Fundus photo. 1444x1444: 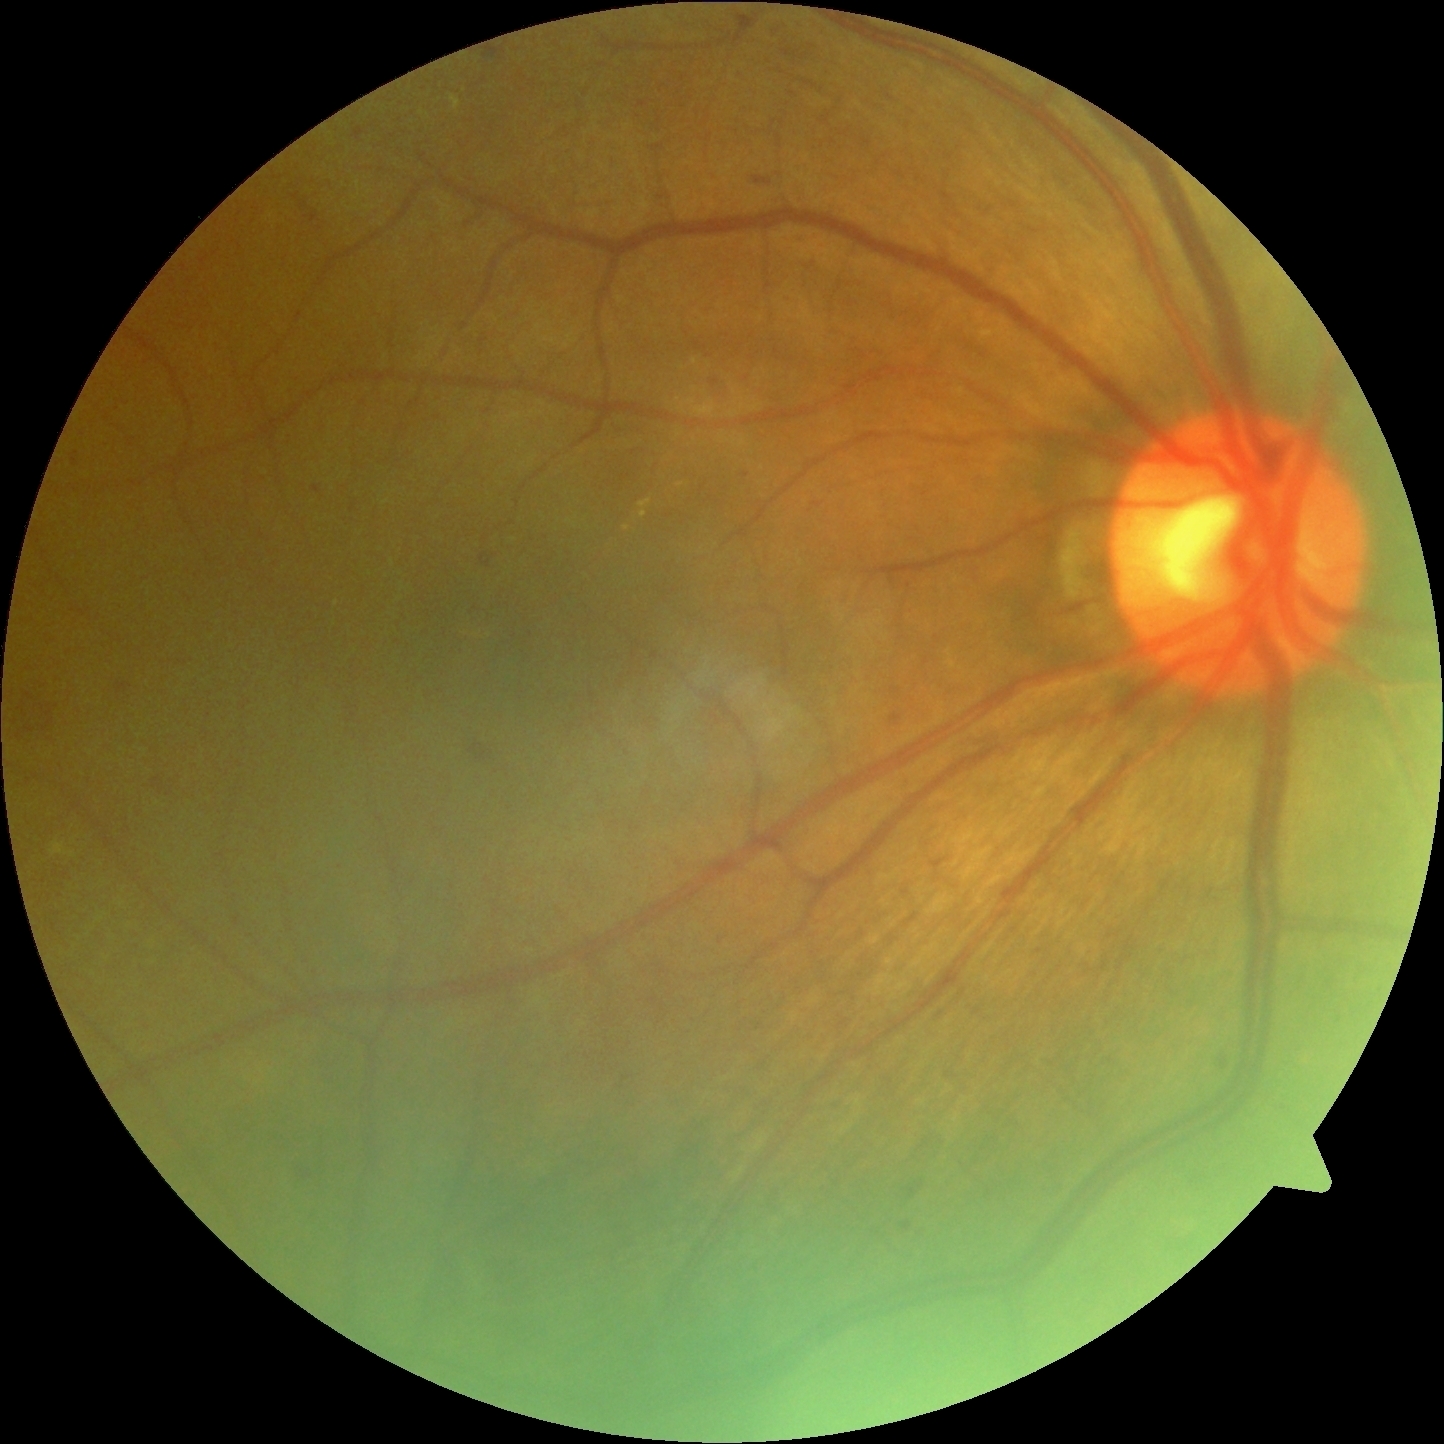

dr_category: non-proliferative diabetic retinopathy
dr_grade: 2/4